Captured with the Natus RetCam Envision (130° field of view); 1440 x 1080 pixels; wide-field fundus image from infant ROP screening: 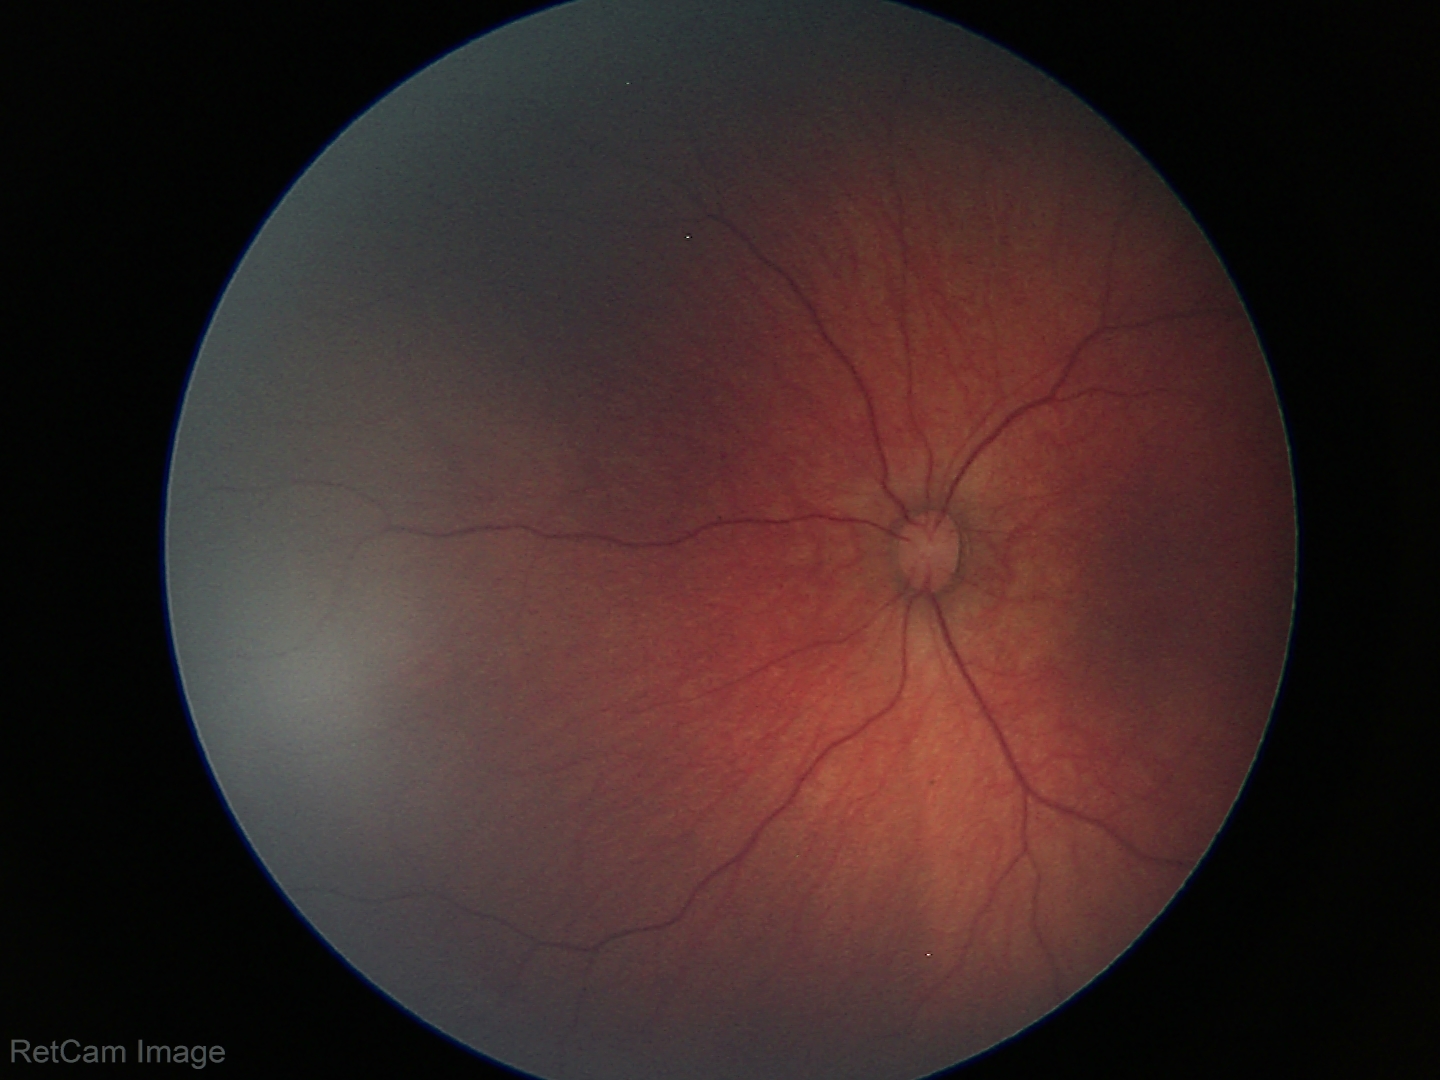
Examination diagnosed as retinal hemorrhages.